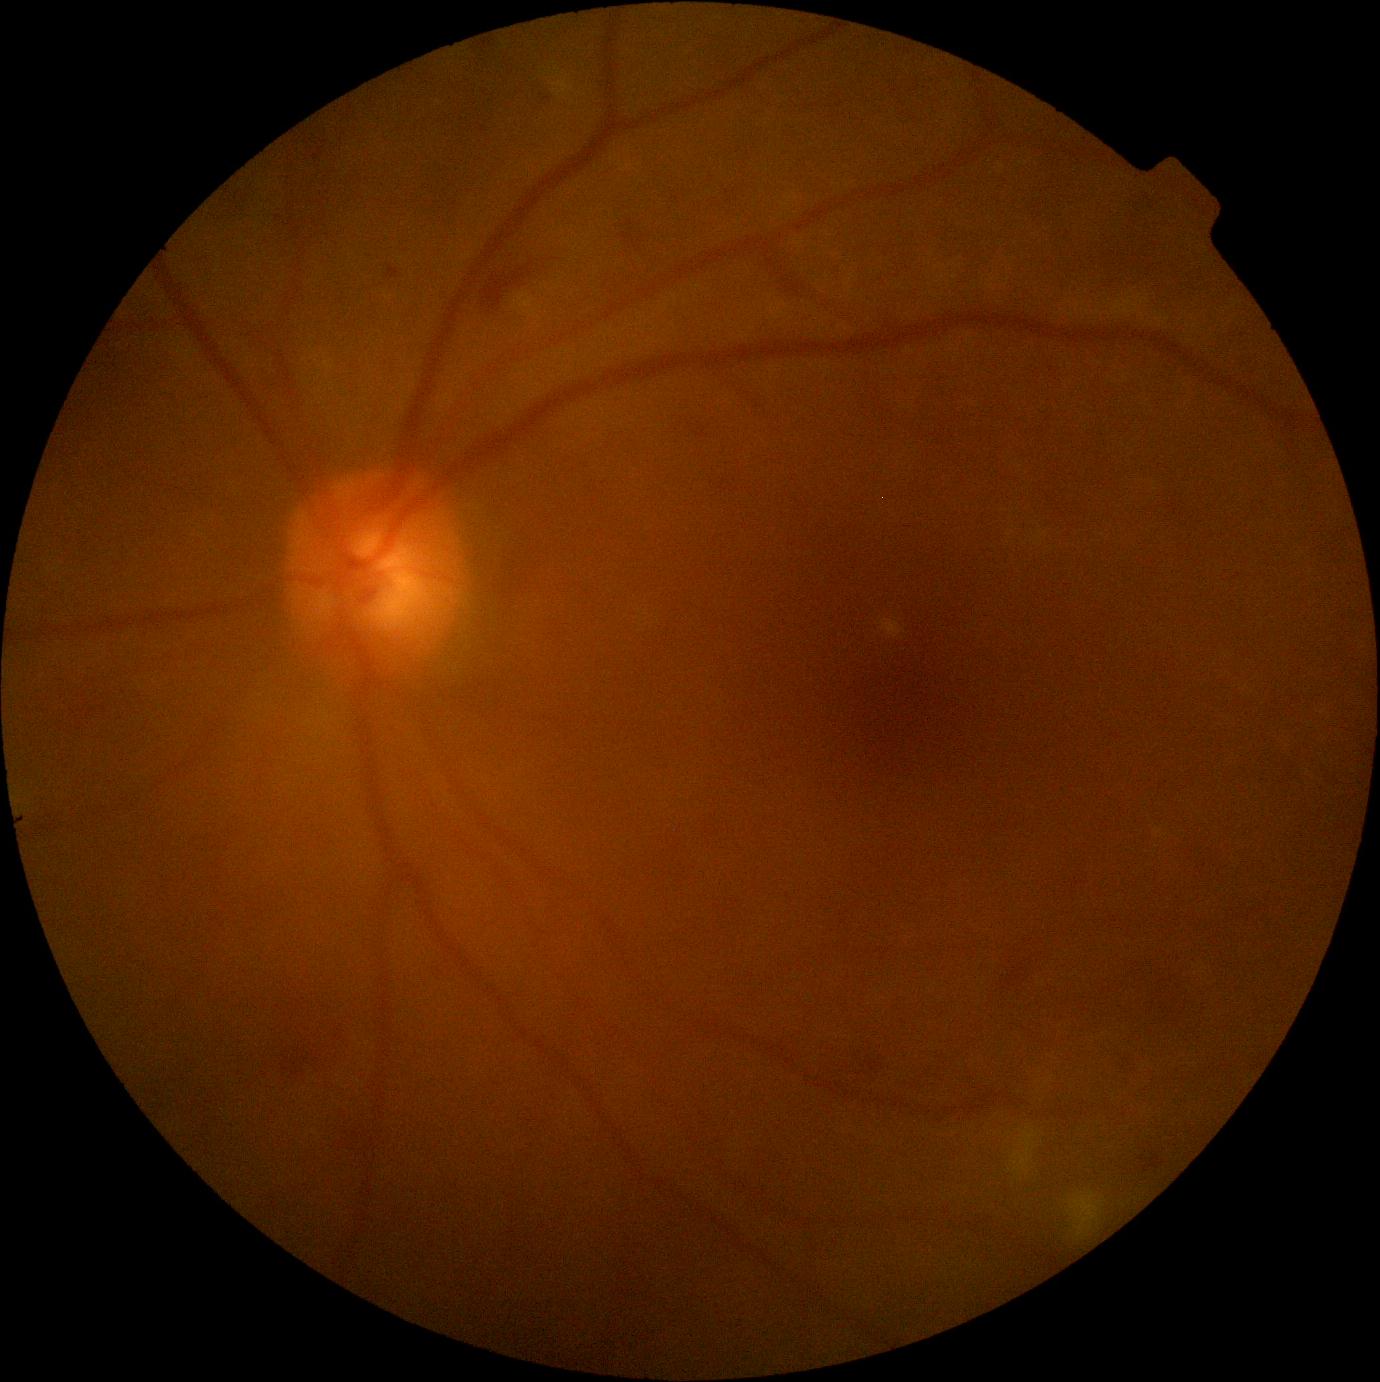
Retinopathy grade is 2 (moderate NPDR) — more than just microaneurysms but less than severe NPDR.